Color fundus image · image size 2352x1568 · FOV: 45 degrees — 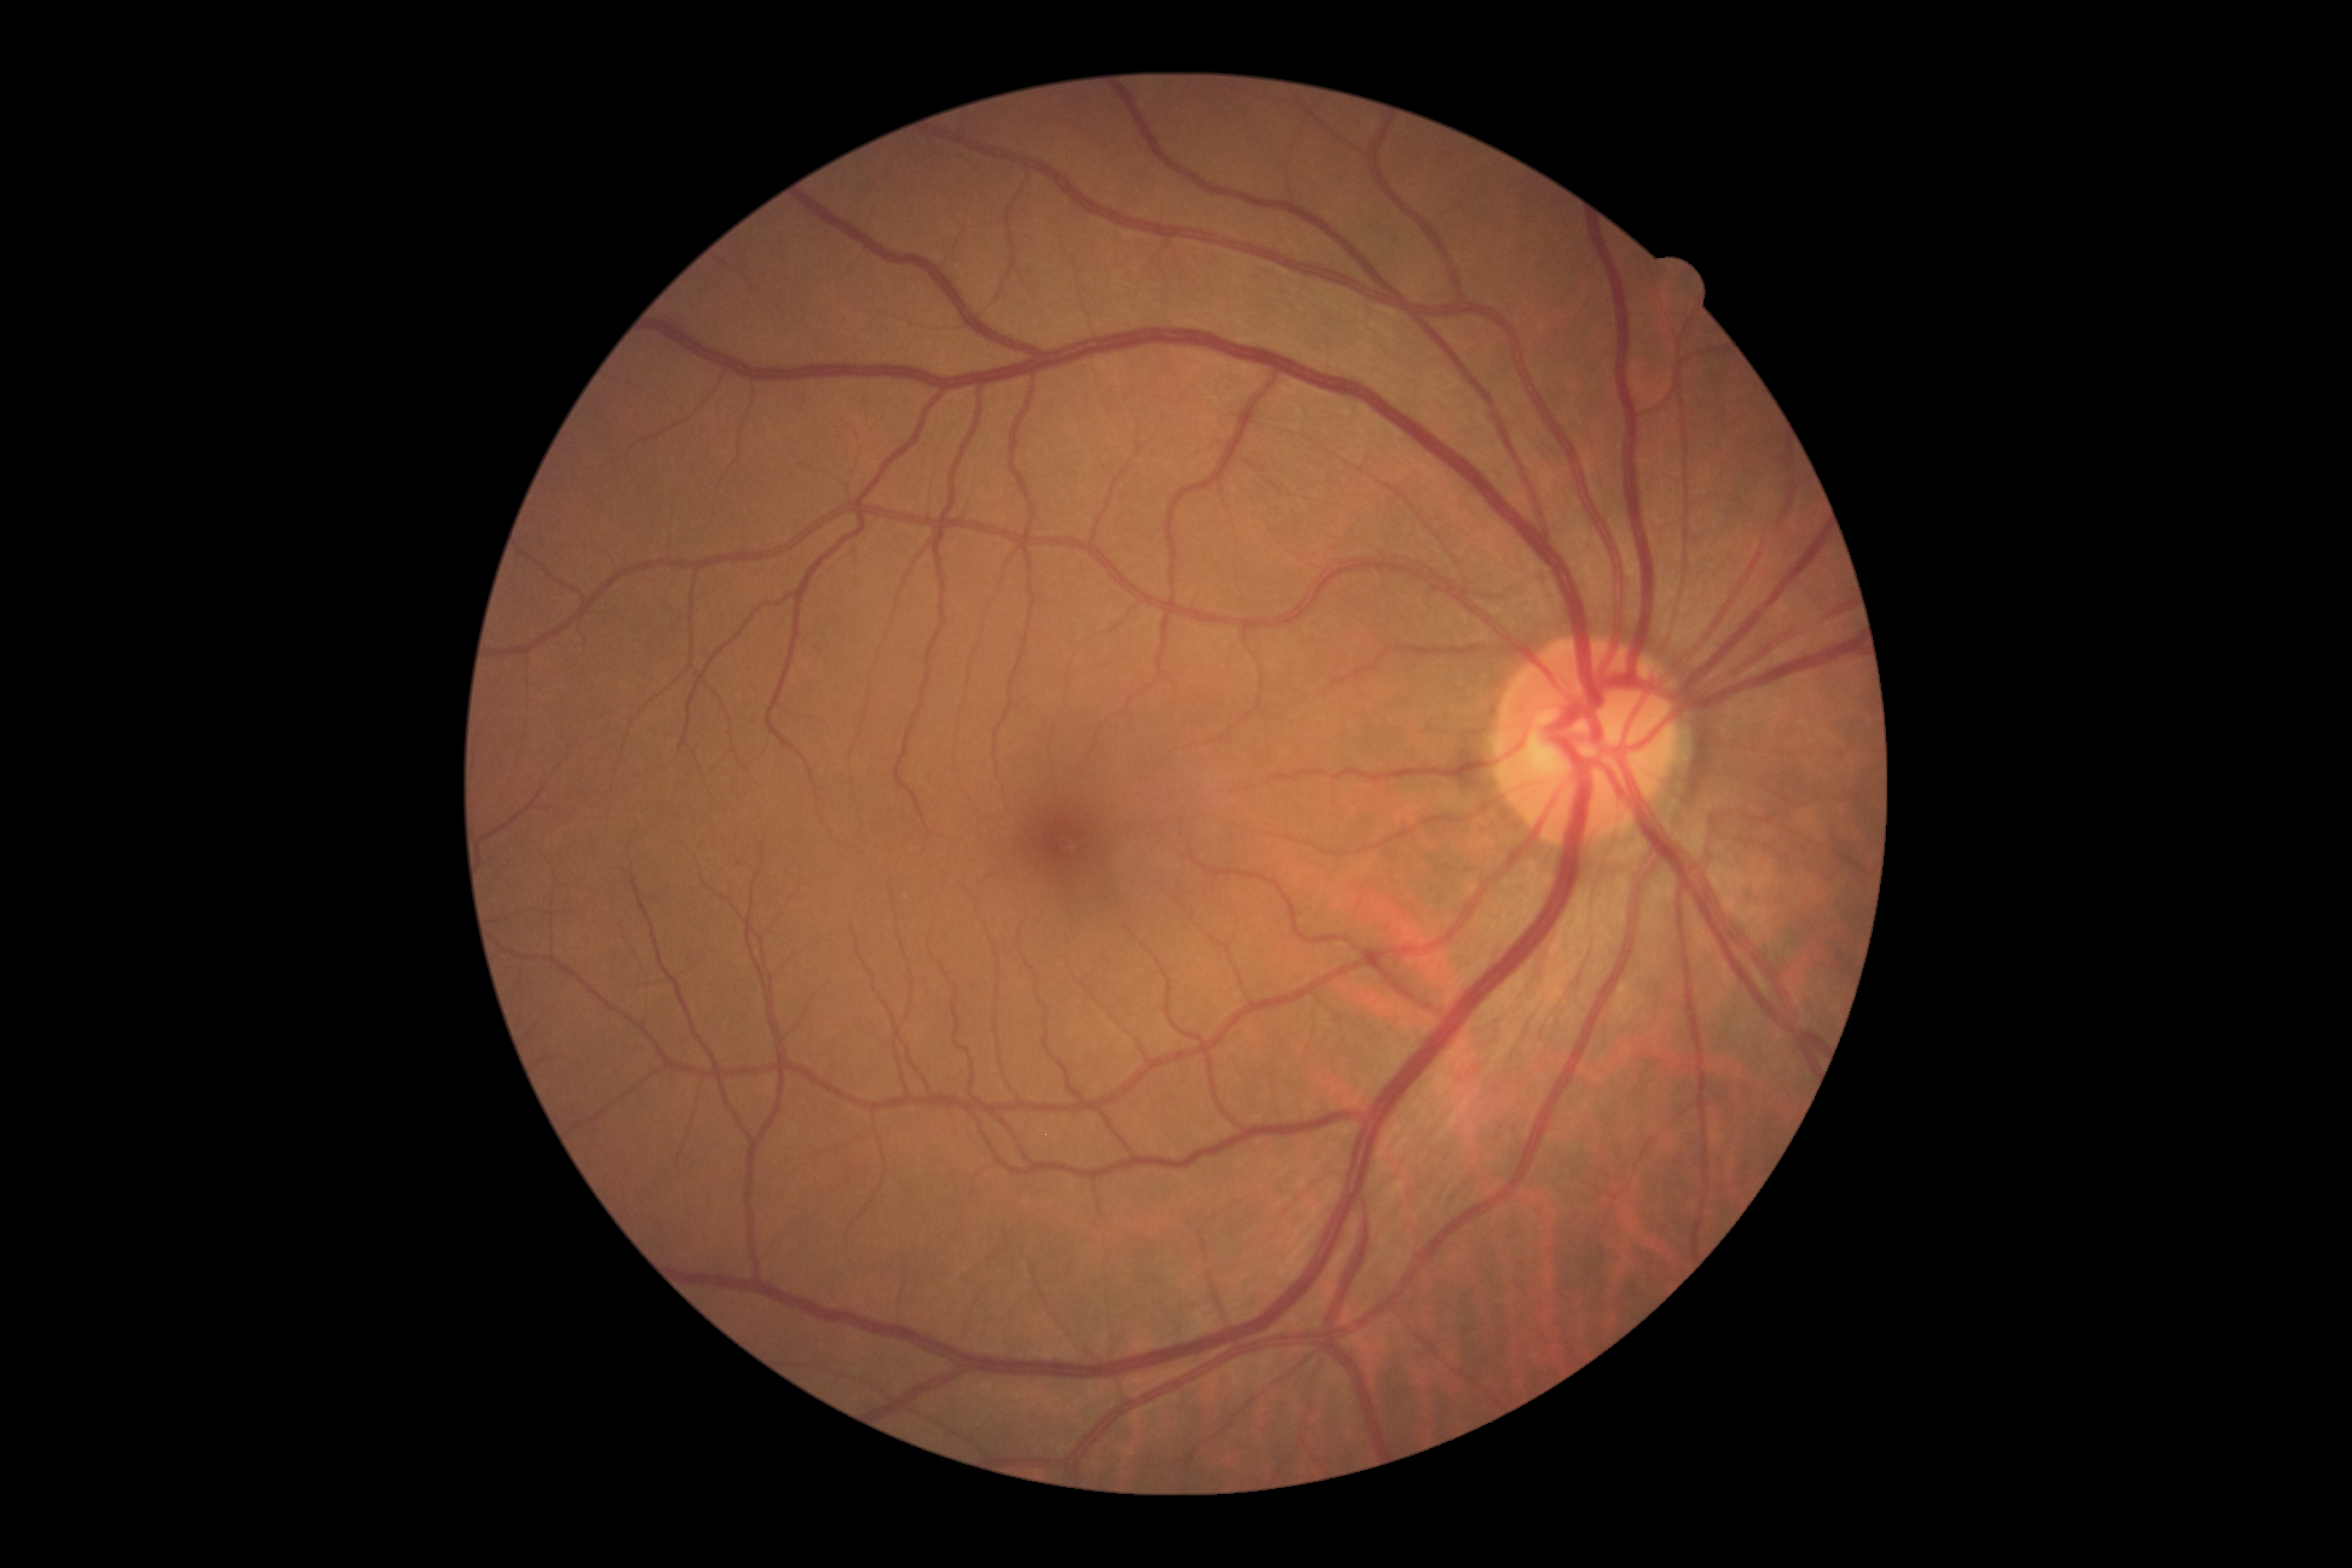

DR grade: 0 — no visible signs of diabetic retinopathy. No DR findings.